Captured on a Remidio smartphone fundus camera:
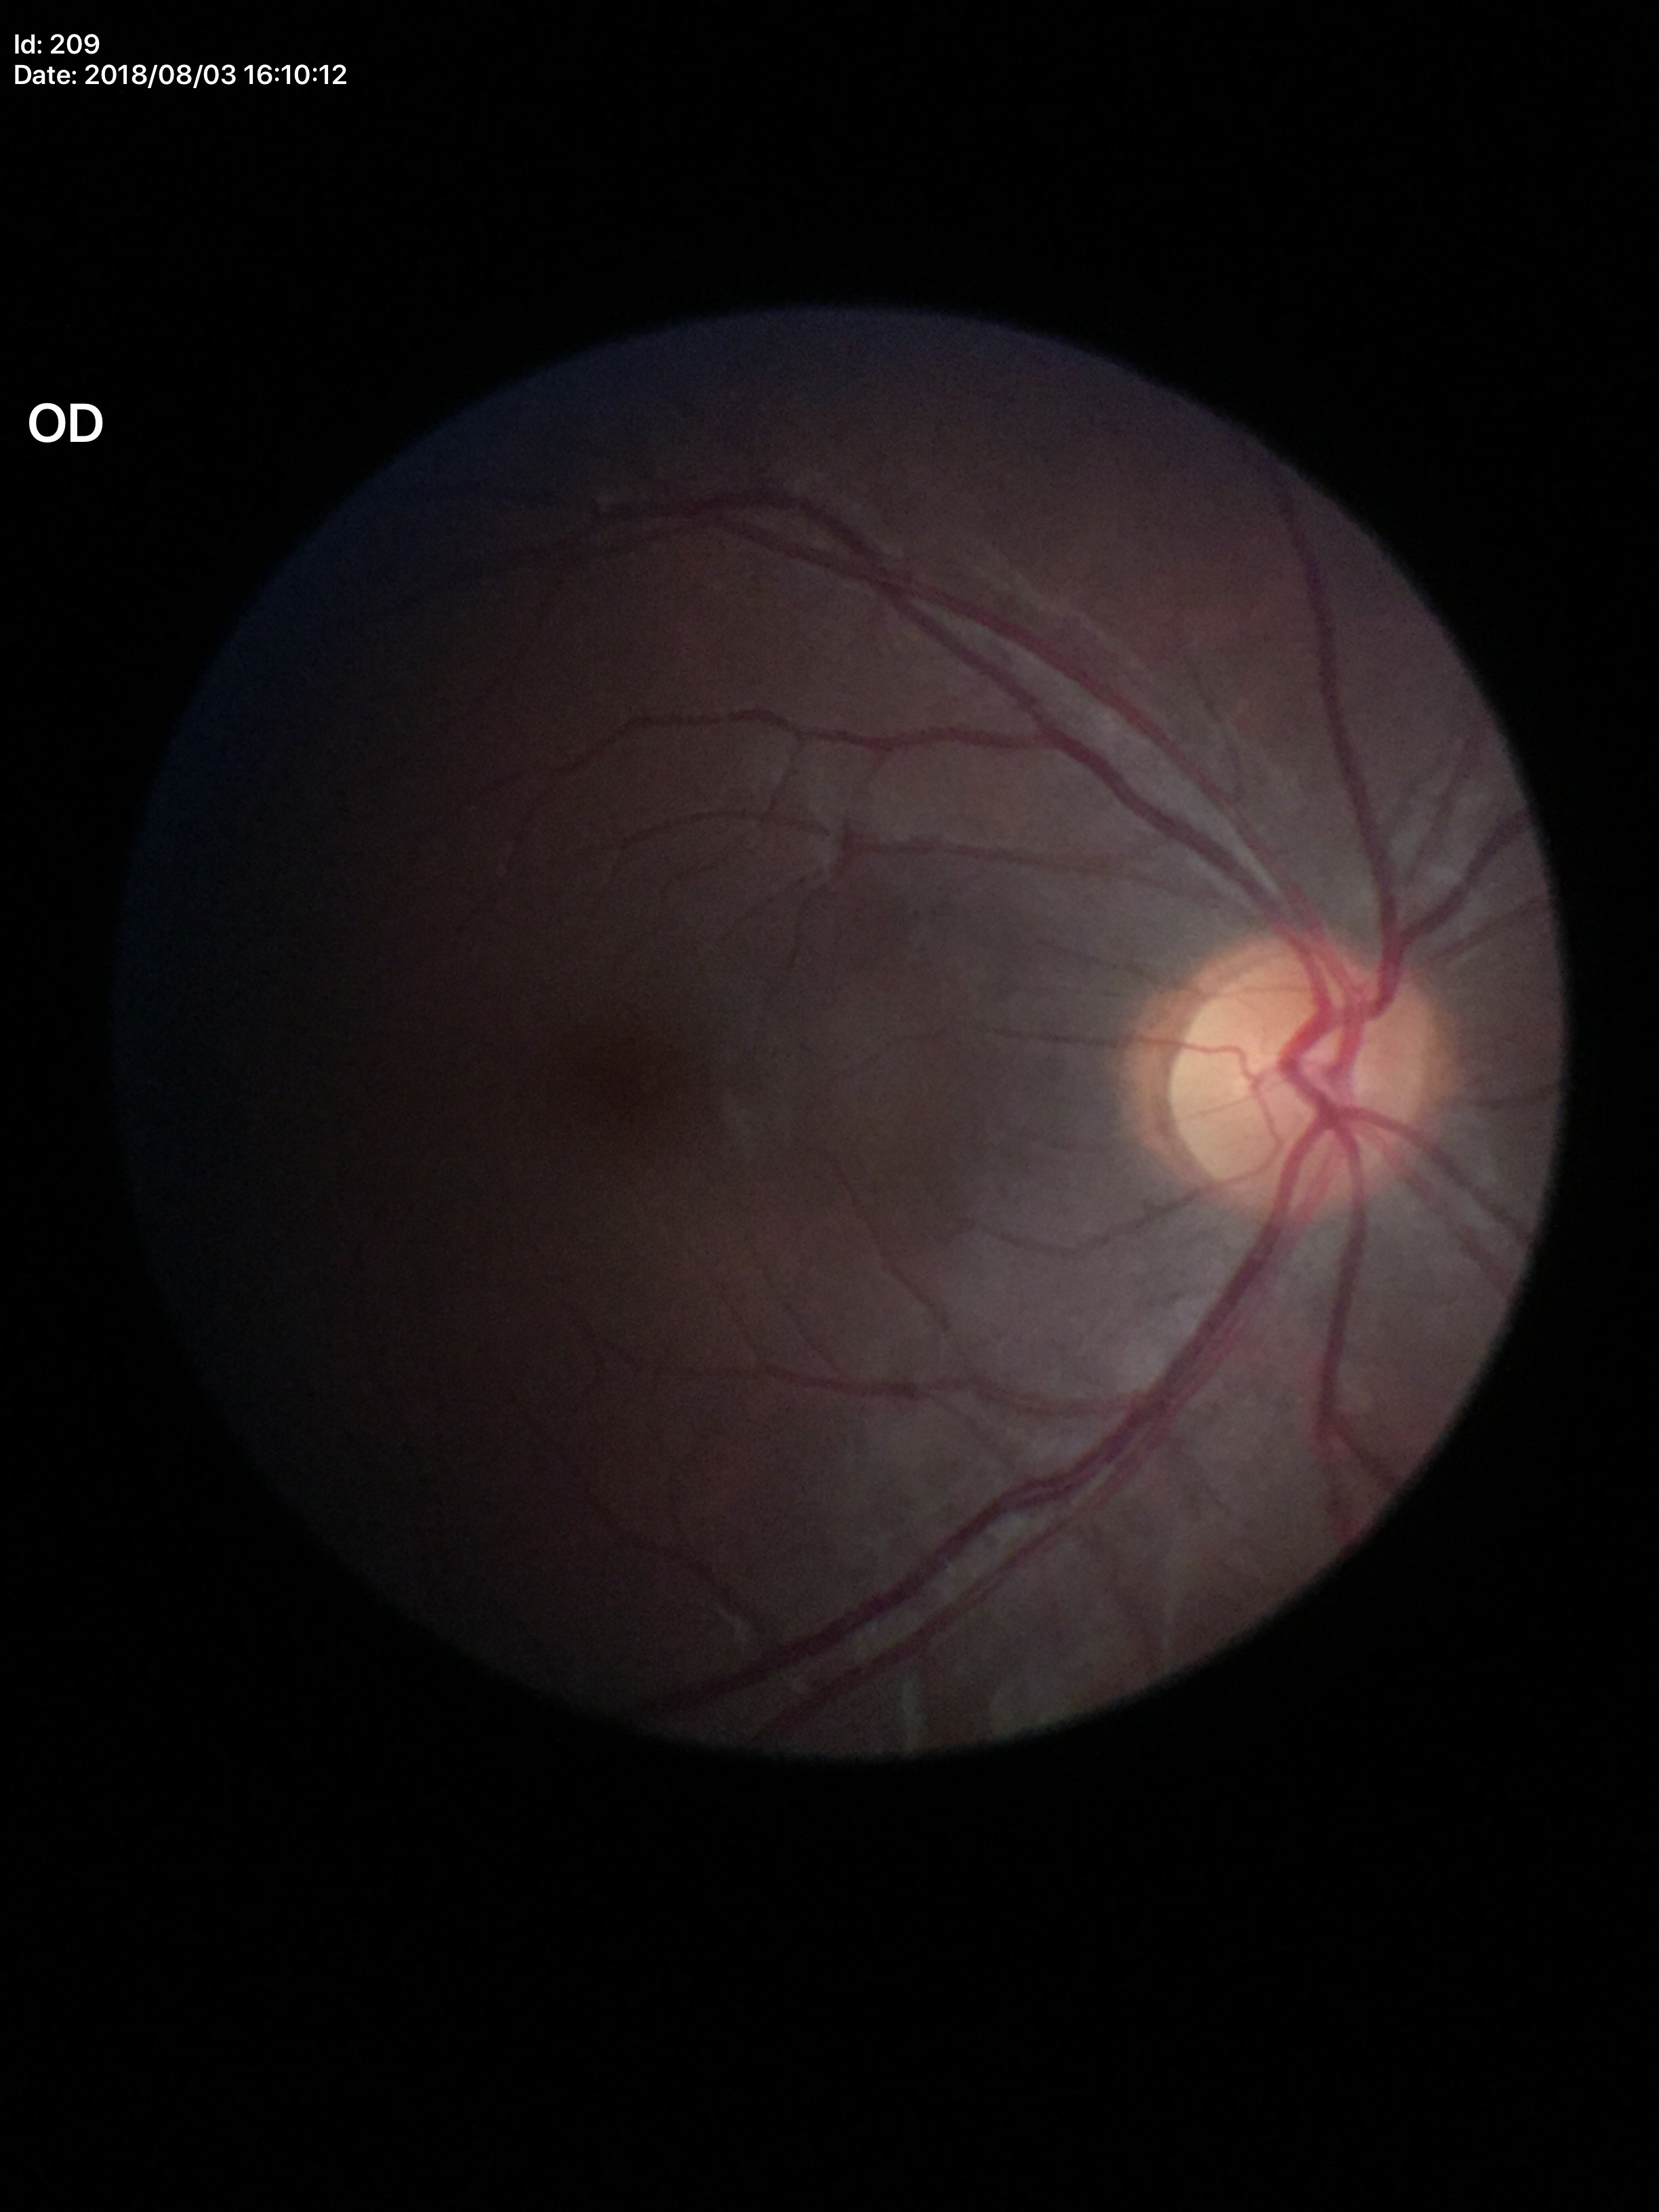
Glaucoma screening impression: no suspicious findings. Vertical CDR (VCDR) is 0.47. Area C/D ratio (ACDR) is 0.23.